45° field of view, 2352 x 1568 pixels.
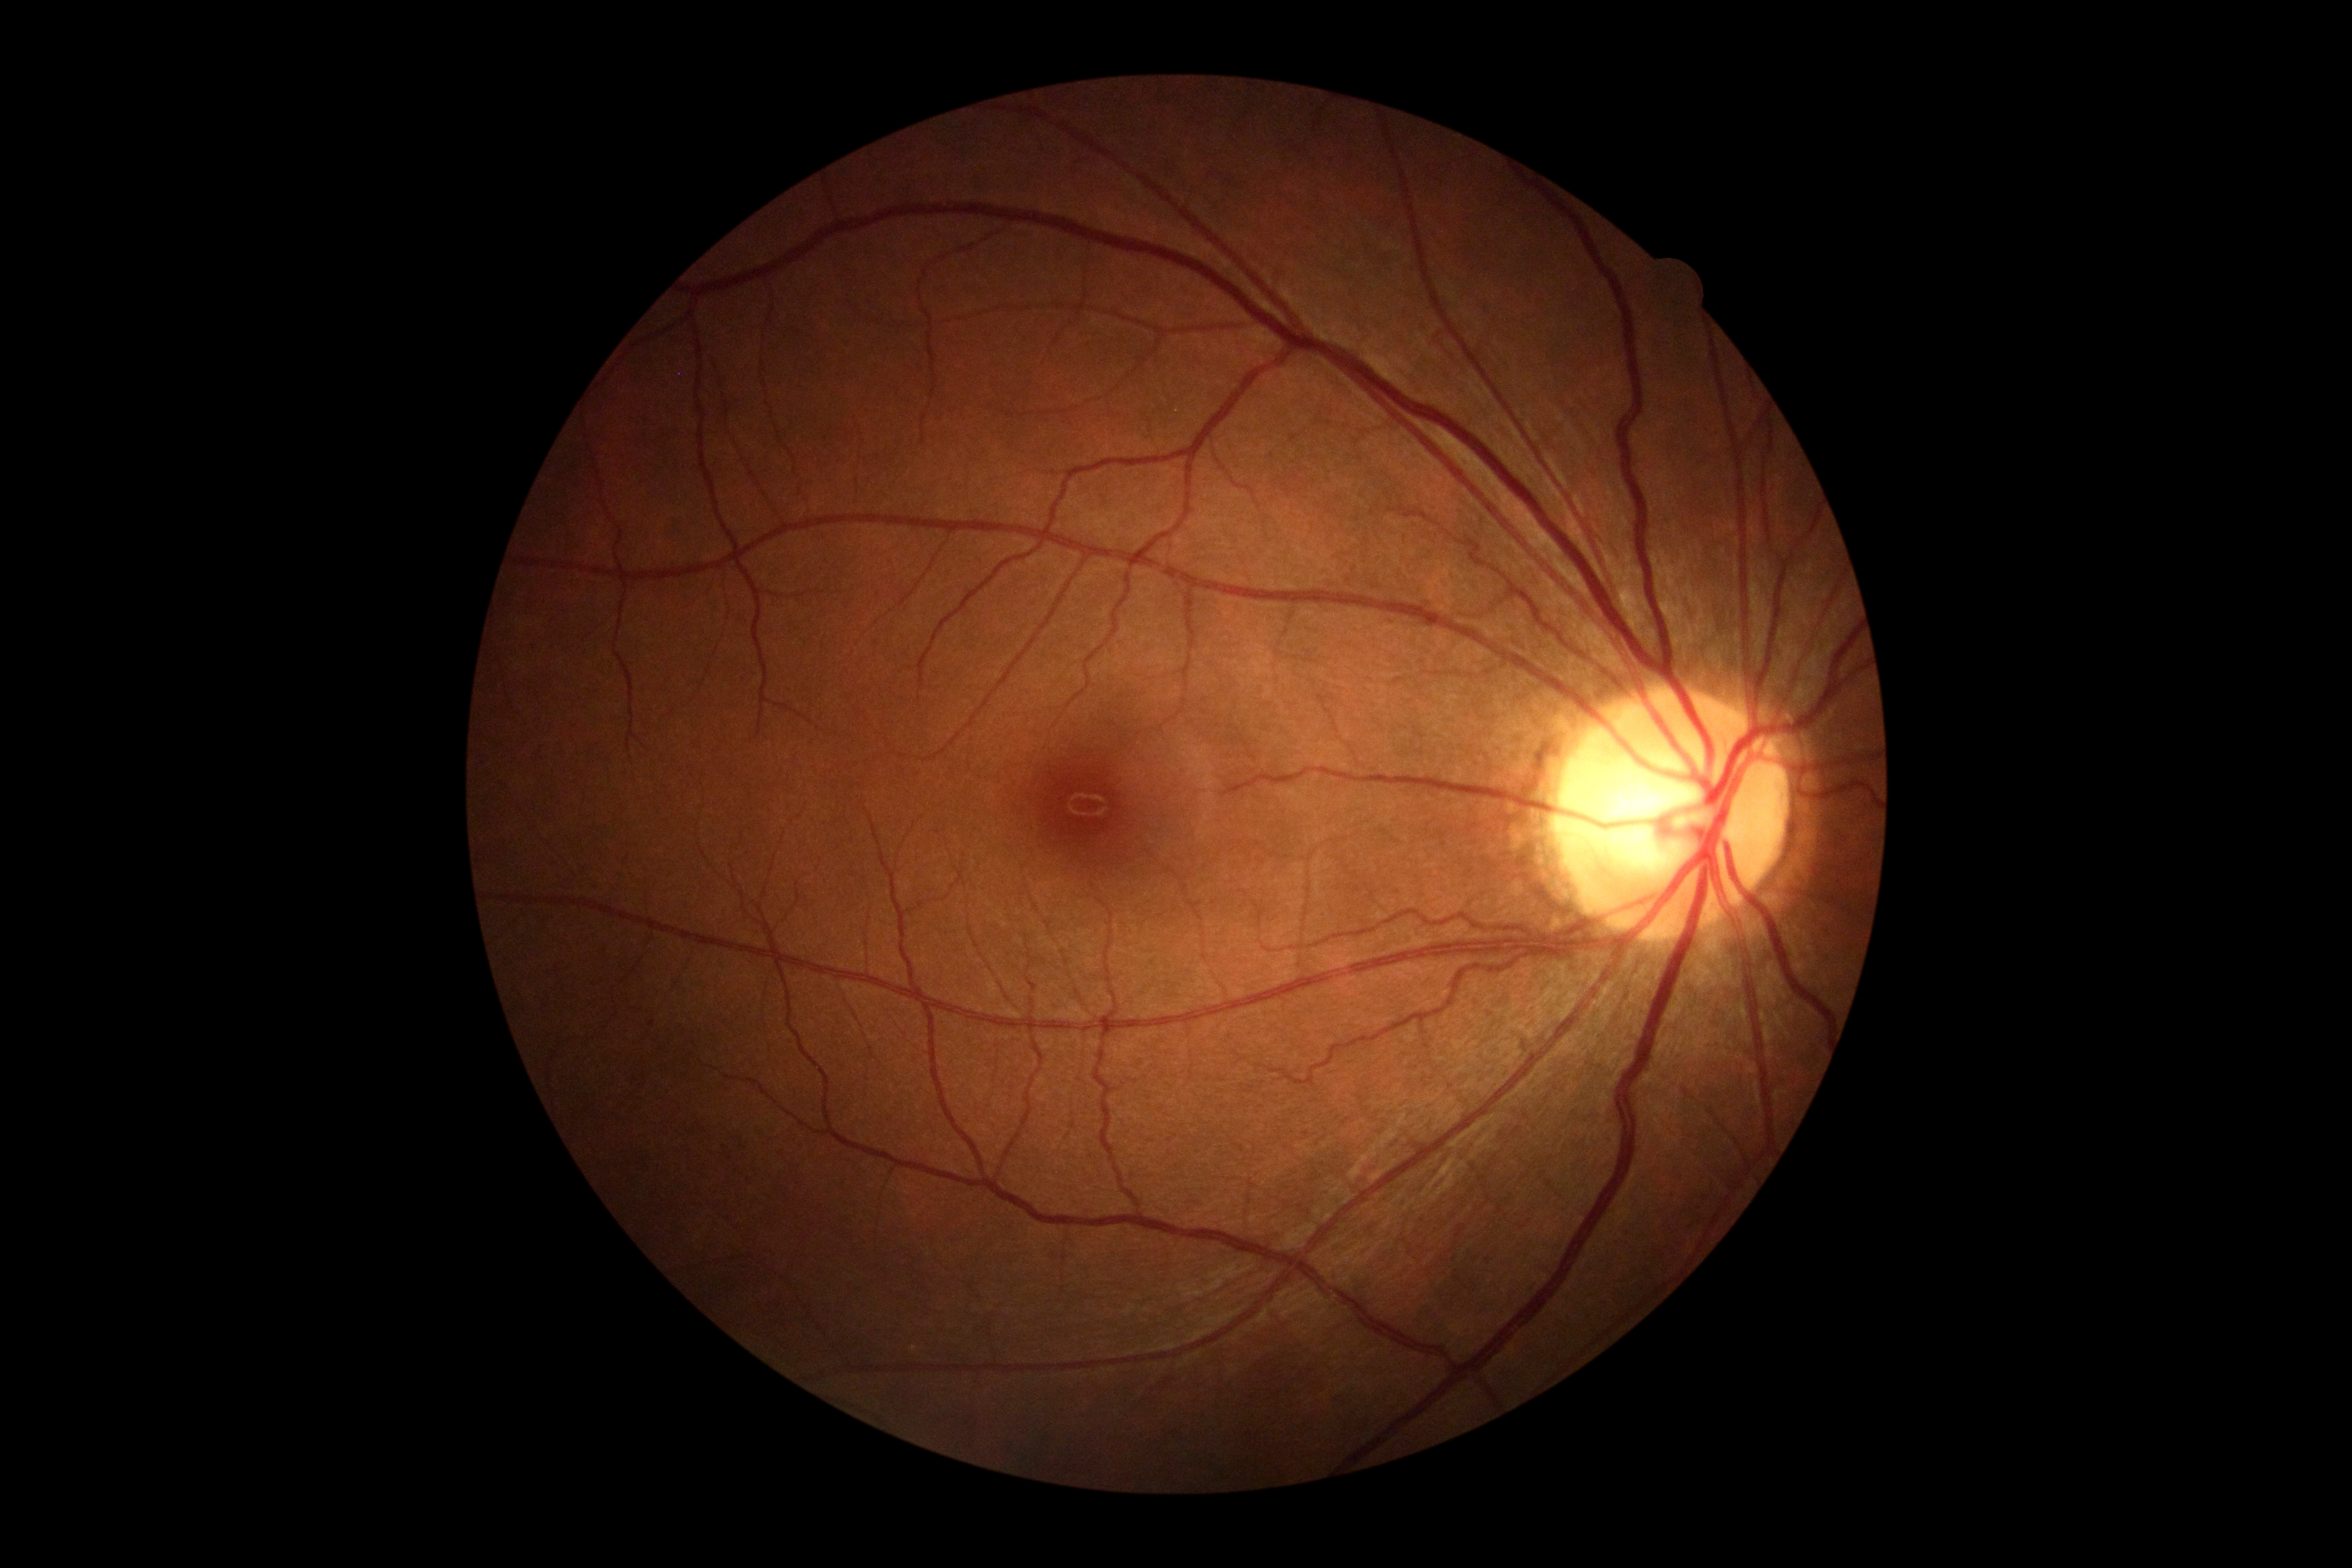
DR grade: no apparent retinopathy (0) — no visible signs of diabetic retinopathy.